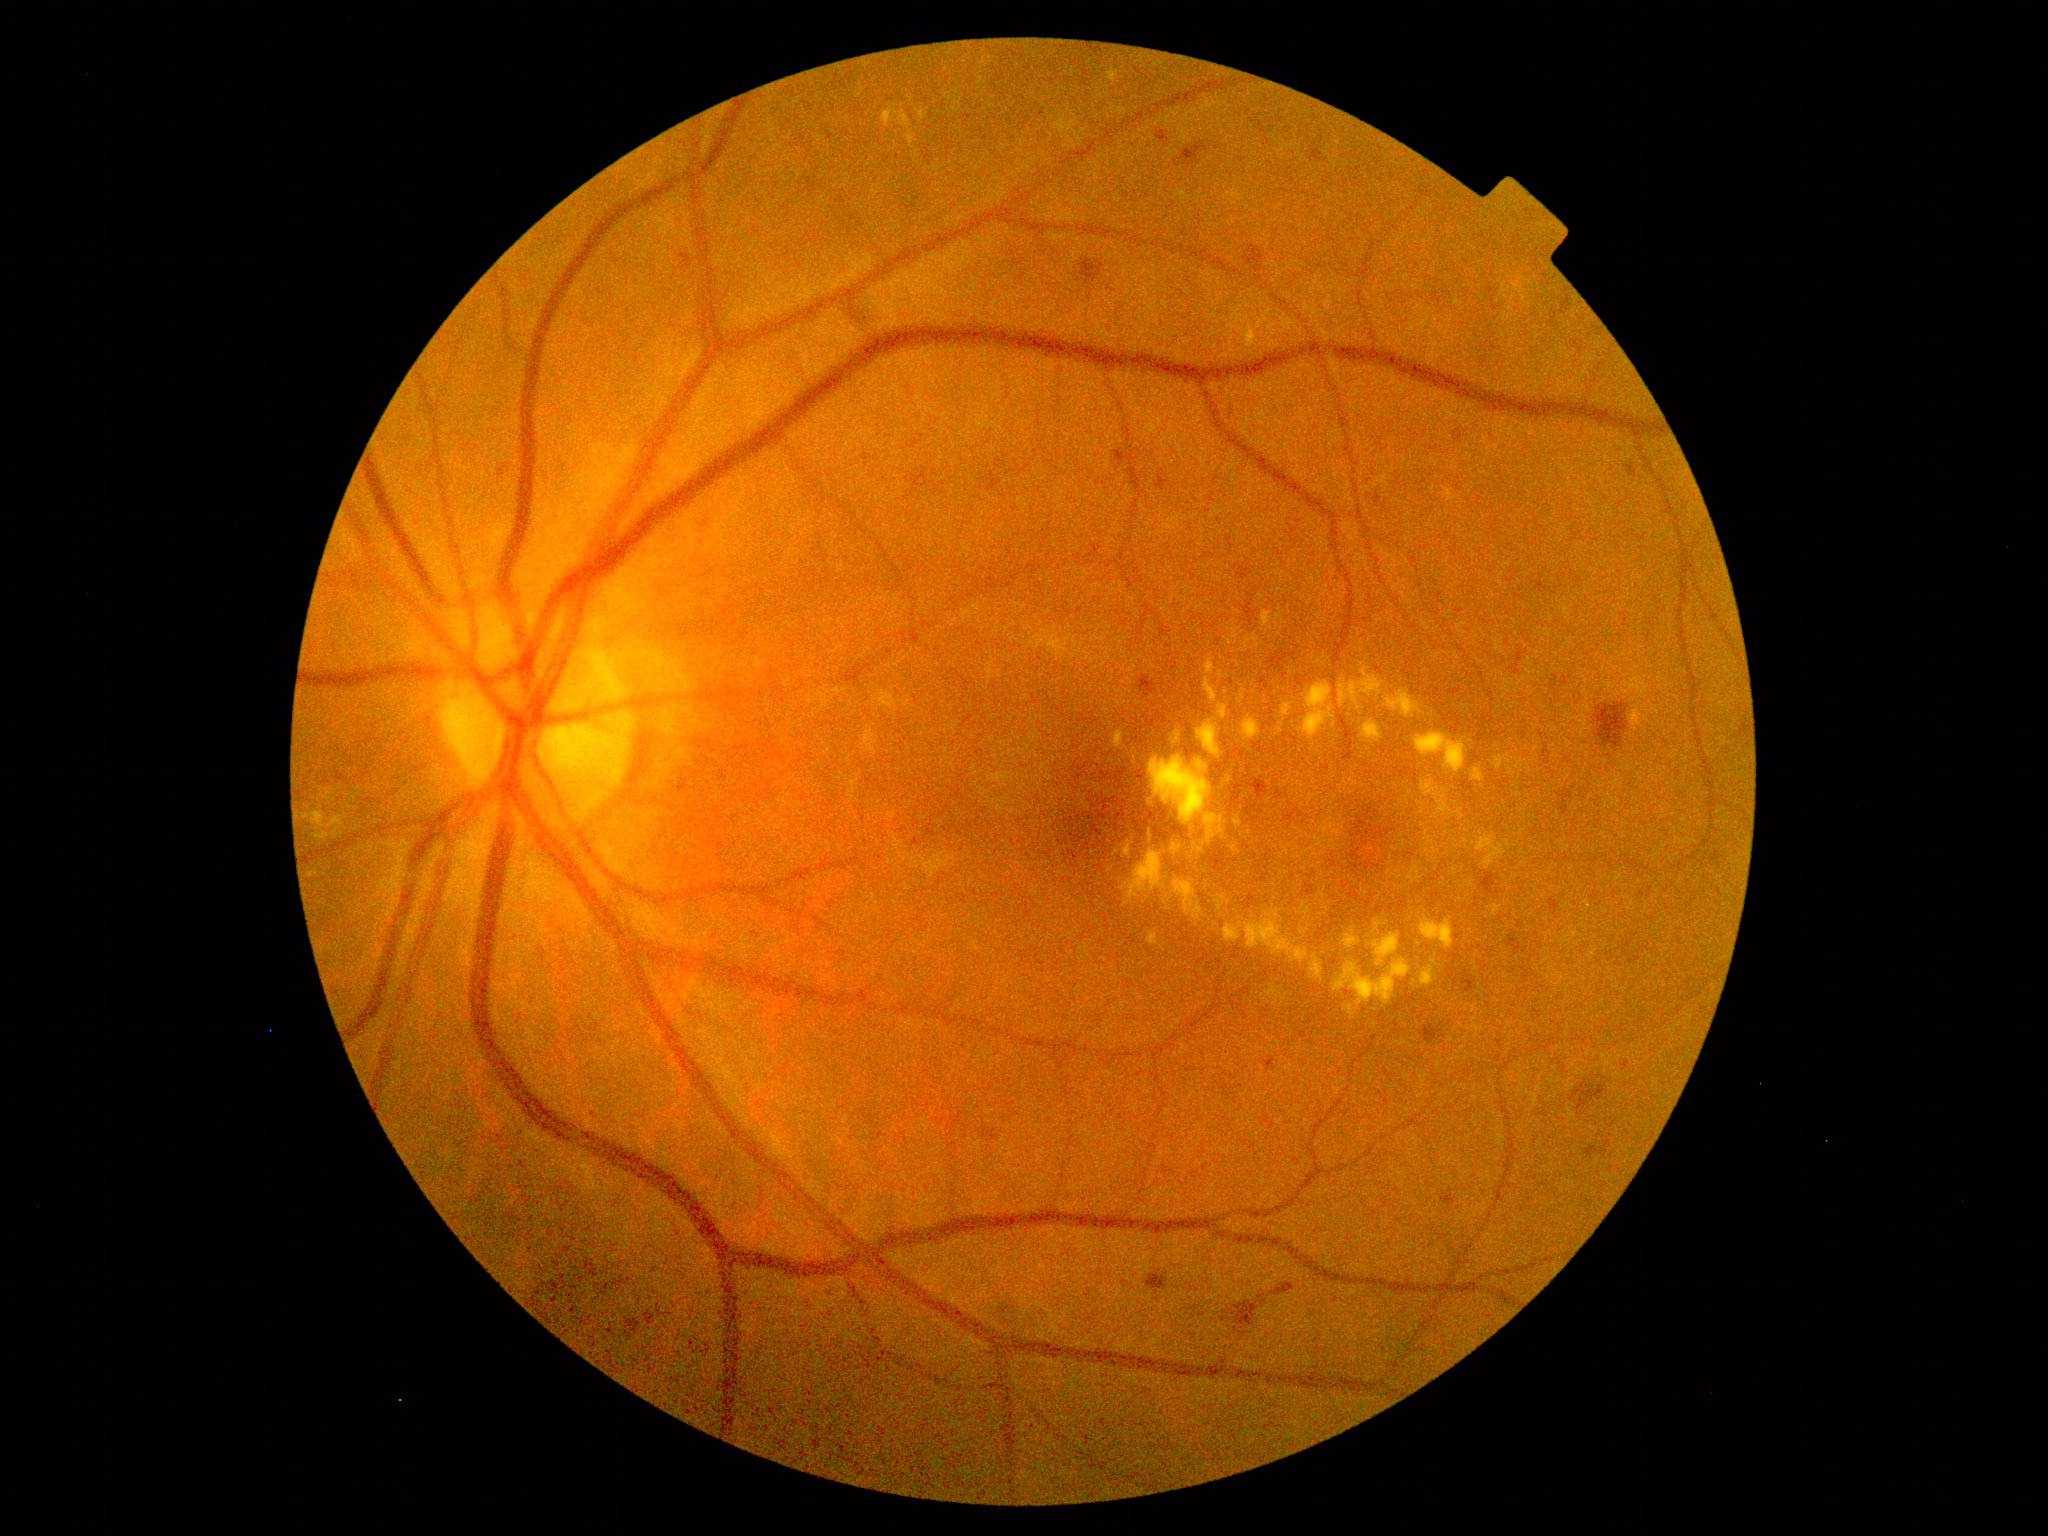

{"partial":true,"dr_grade":2,"lesions":{"ex":[[1312,780,1320,790],[1196,719,1222,759],[1298,682,1337,742],[1238,325,1261,346],[1218,671,1225,679],[1216,895,1226,912],[1407,865,1424,884],[1300,925,1311,936]],"ex_small_approx":[[1507,977],[1283,725],[1323,903],[1111,725],[1480,986],[1325,808],[1132,671],[1293,792],[1232,975],[1191,978],[1308,838]]}}